1240x1240px. Wide-field fundus image from infant ROP screening
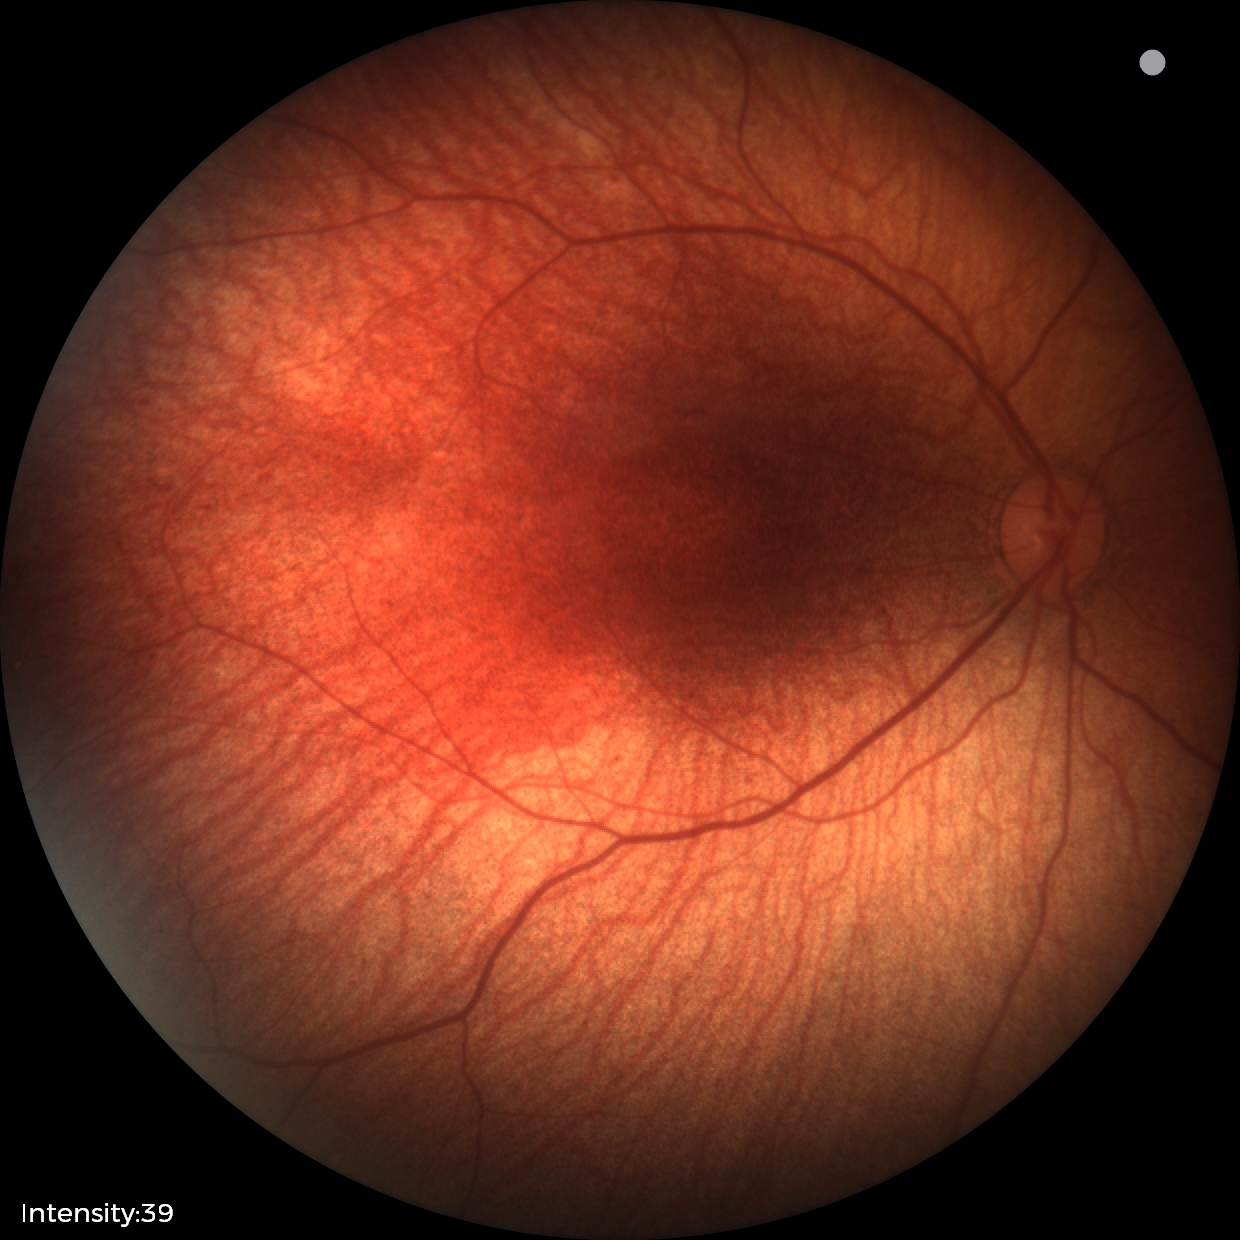 Screening examination diagnosed as physiological.